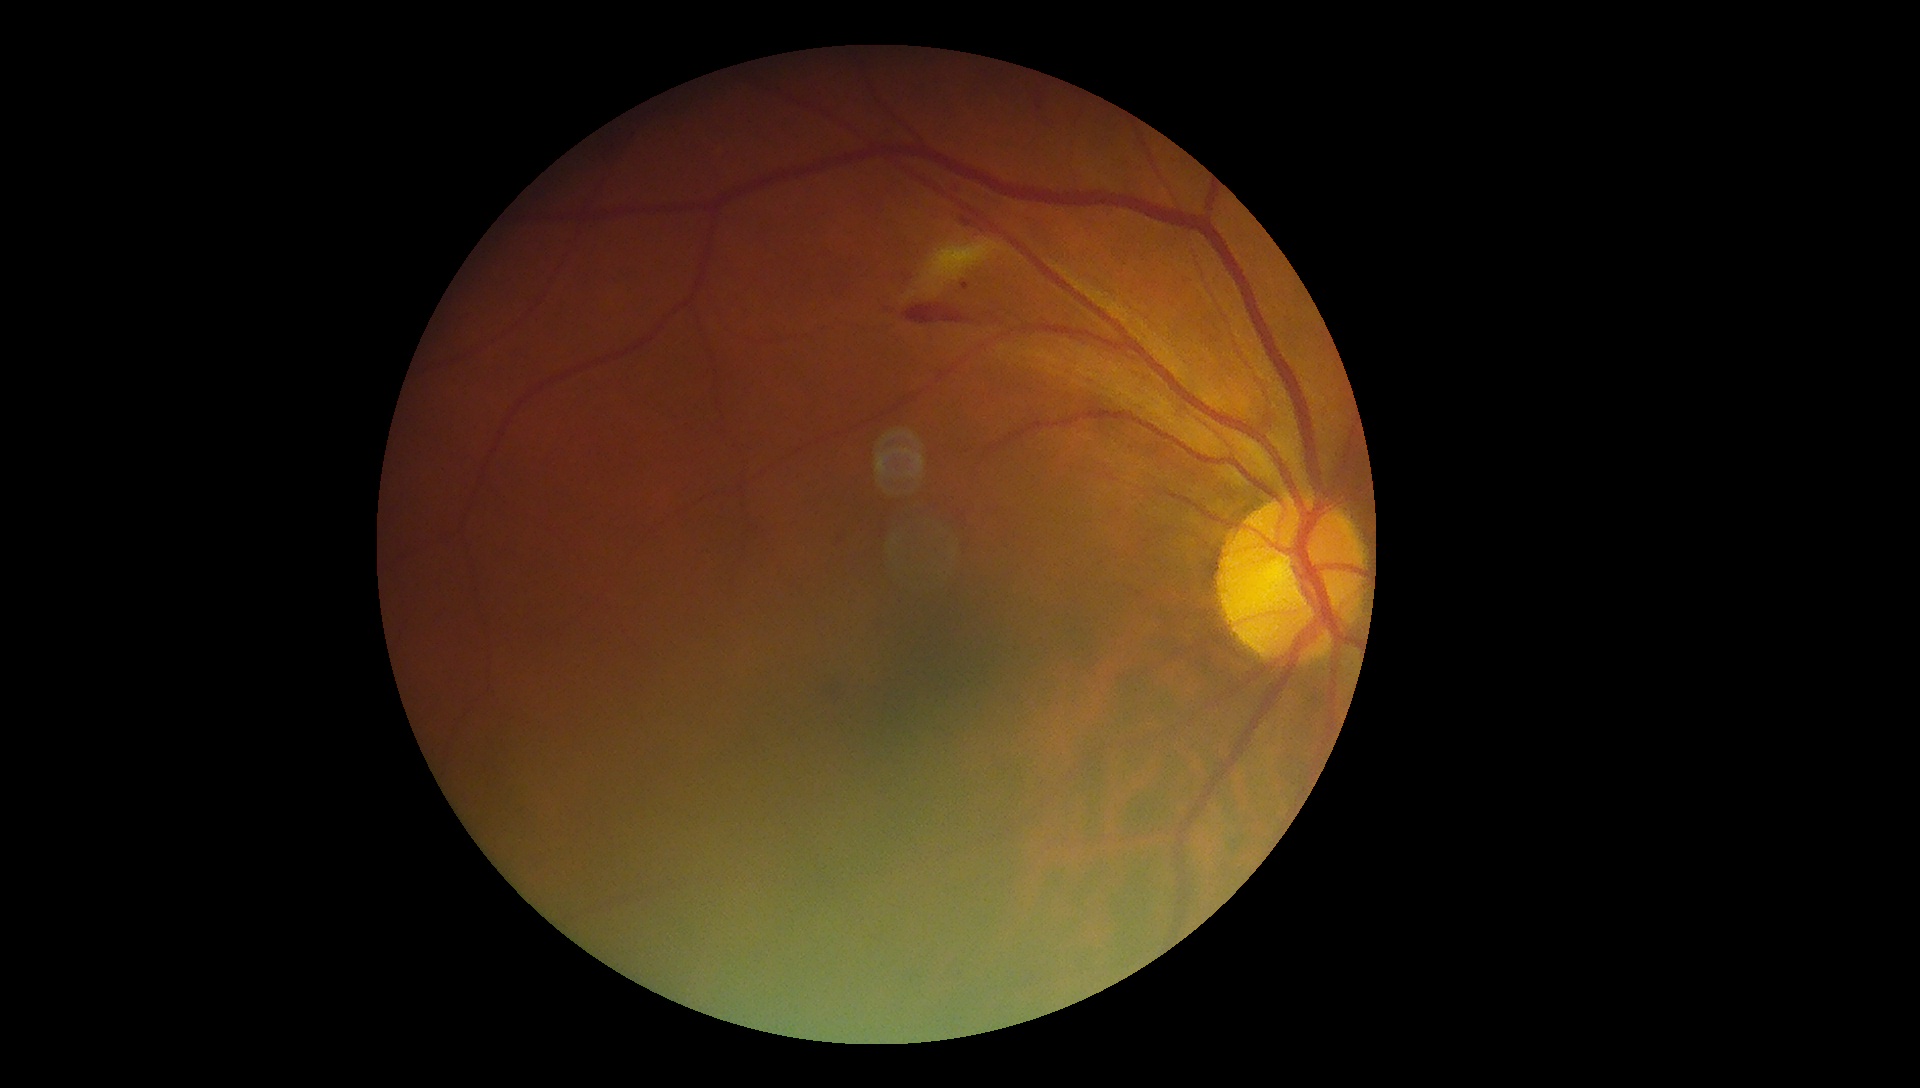 DR class=non-proliferative diabetic retinopathy, DR grade=moderate non-proliferative diabetic retinopathy (2).